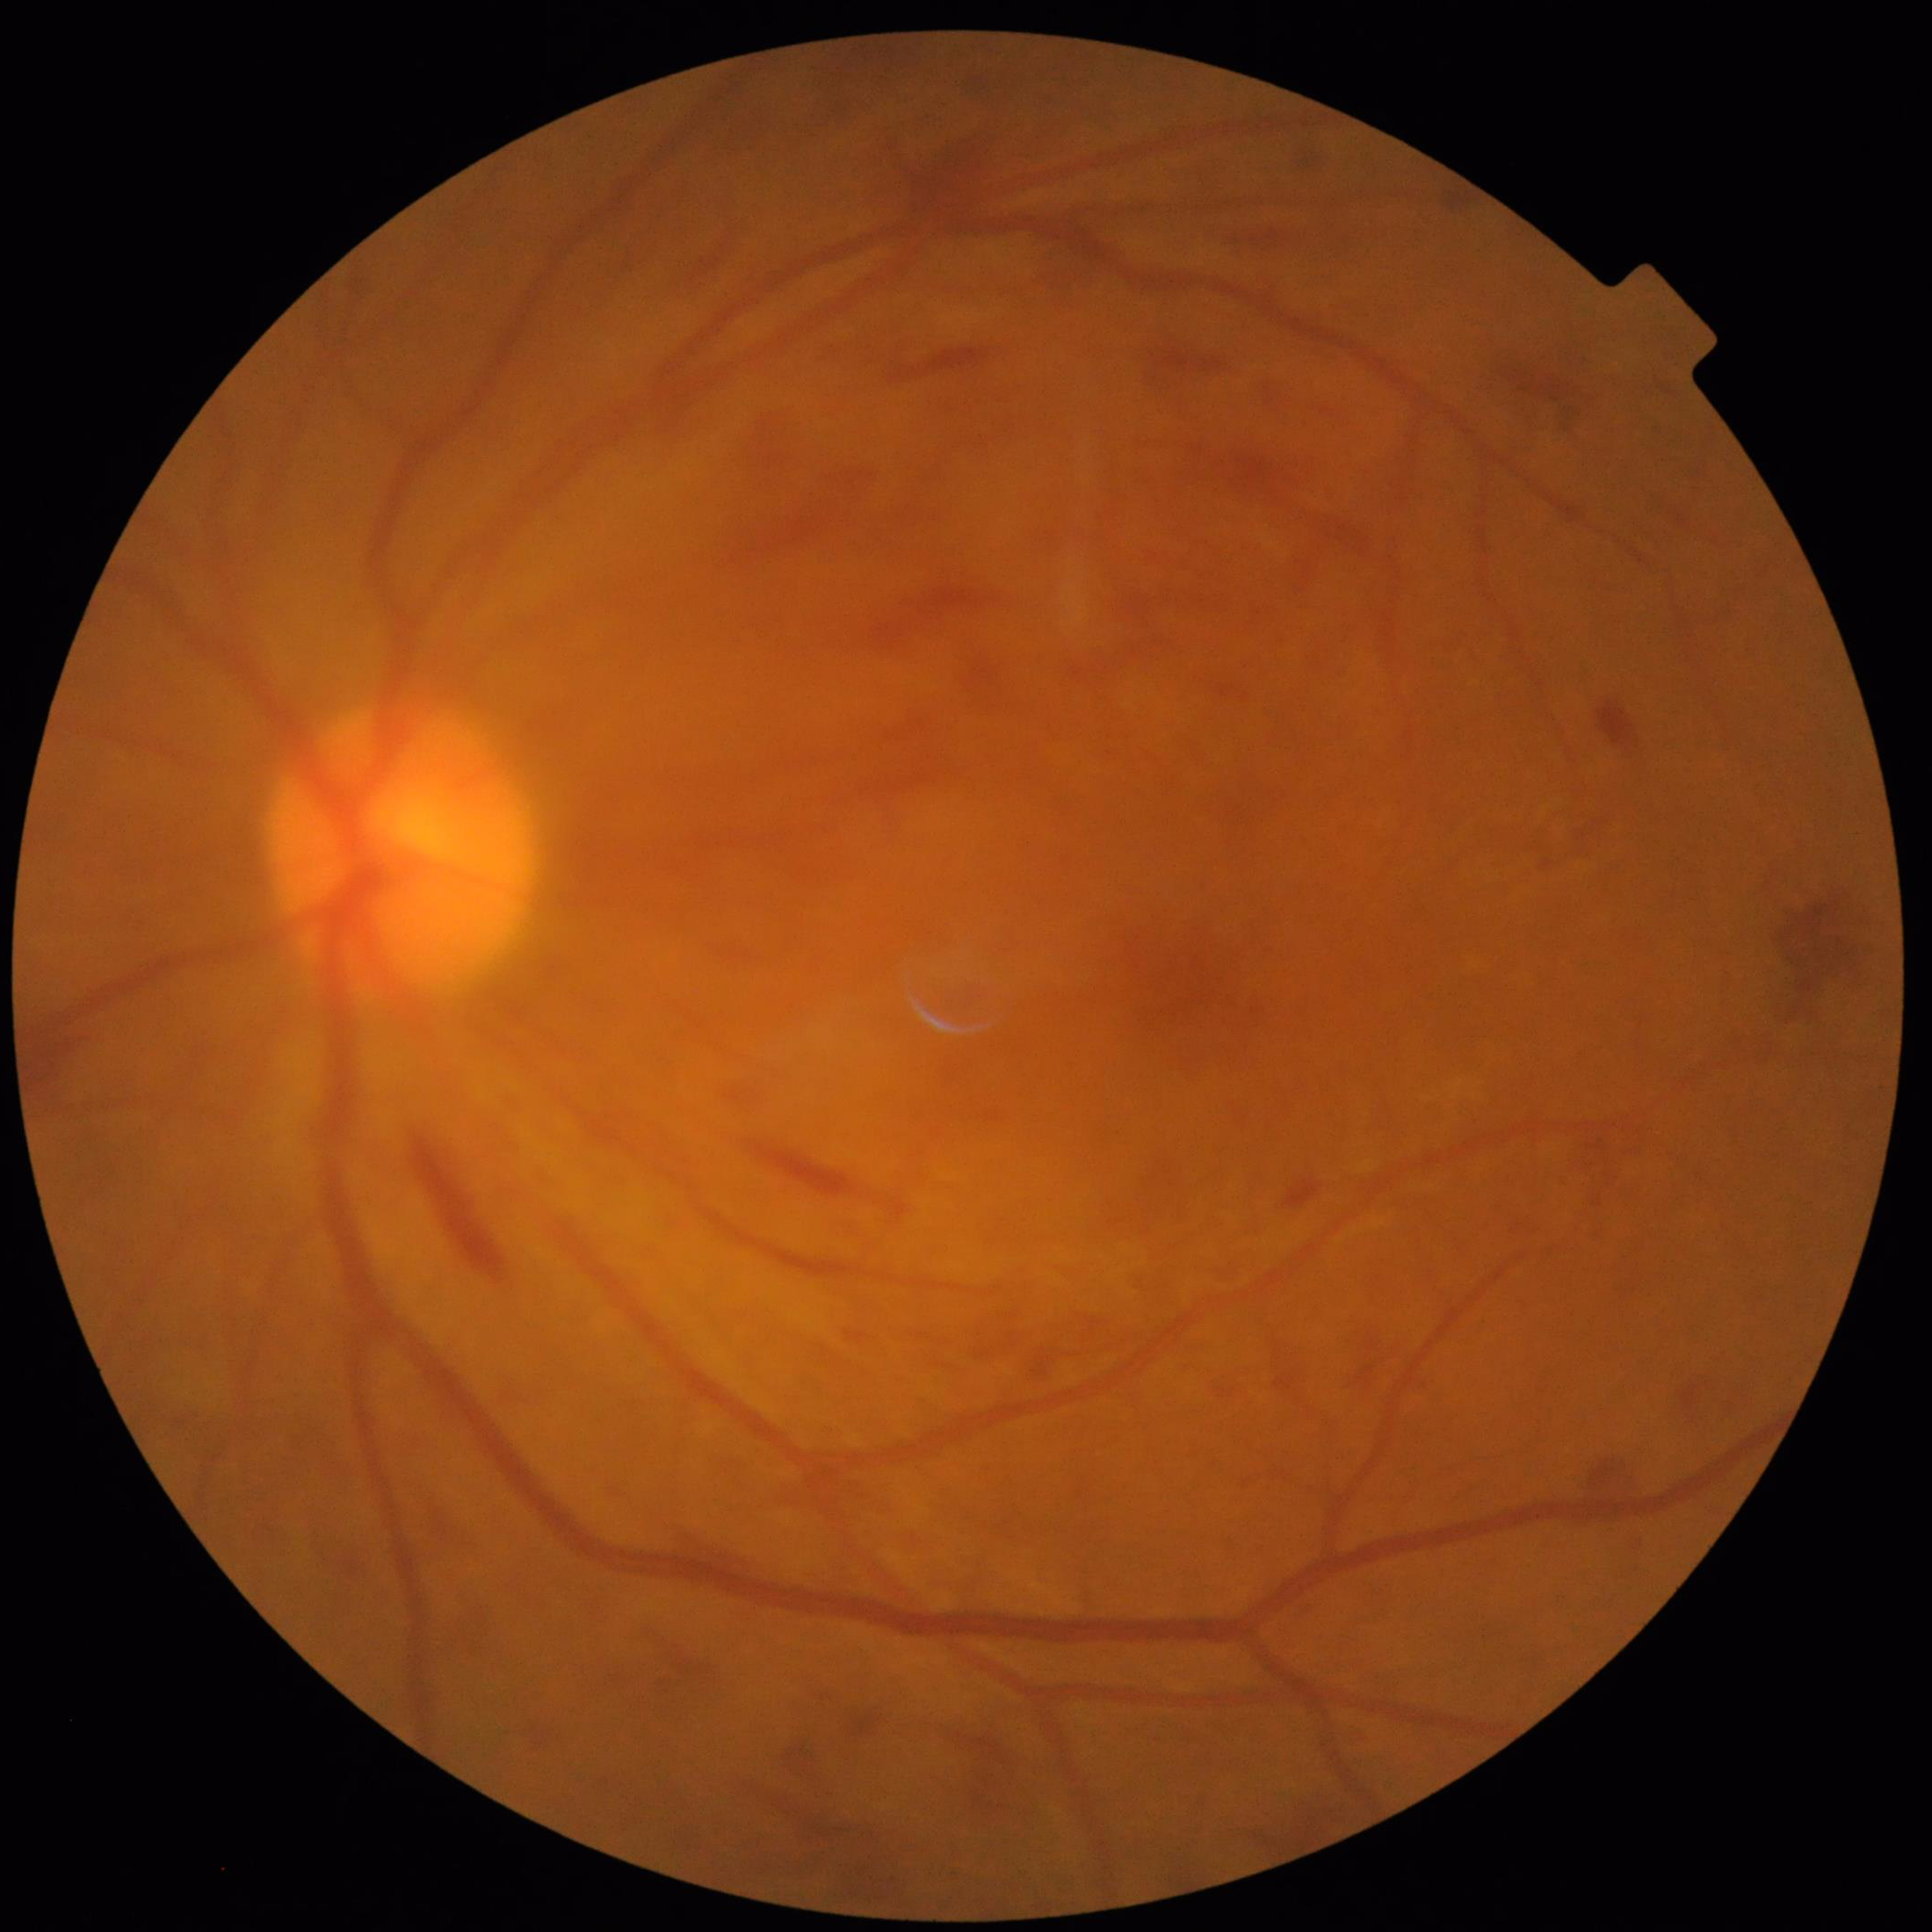

Quality: contrast adequate, illumination and color satisfactory, blur present. From a patient with diabetic retinopathy (DR).